Nonmydriatic fundus photograph
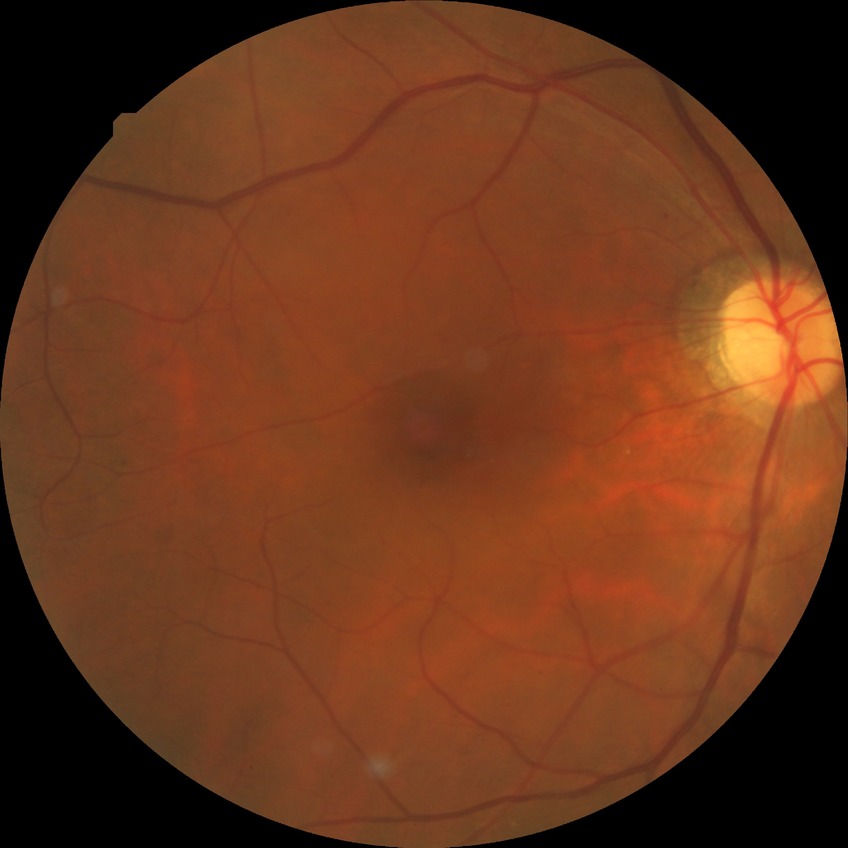

DR is SDR.